45 degree fundus photograph; diabetic retinopathy graded by the modified Davis classification — 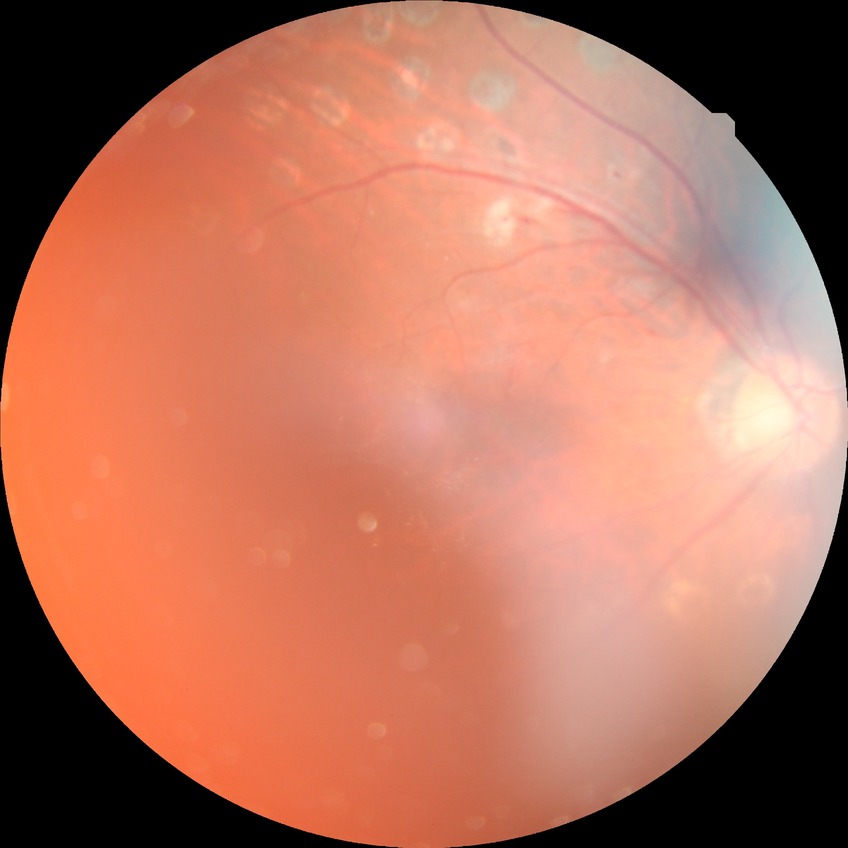
{
  "davis_grade": "PDR (proliferative diabetic retinopathy)"
}